FOV: 45 degrees. Posterior pole color fundus photograph. 848 by 848 pixels. No pharmacologic dilation. Acquired with a NIDEK AFC-230 — 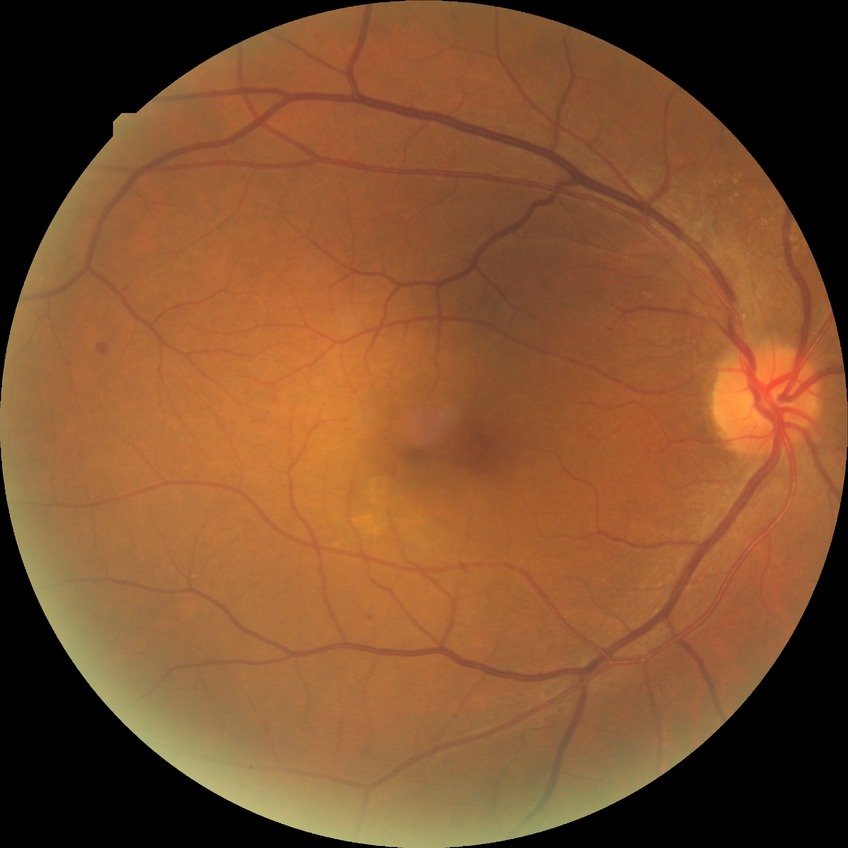 Davis grading: simple diabetic retinopathy.